Davis DR grading:
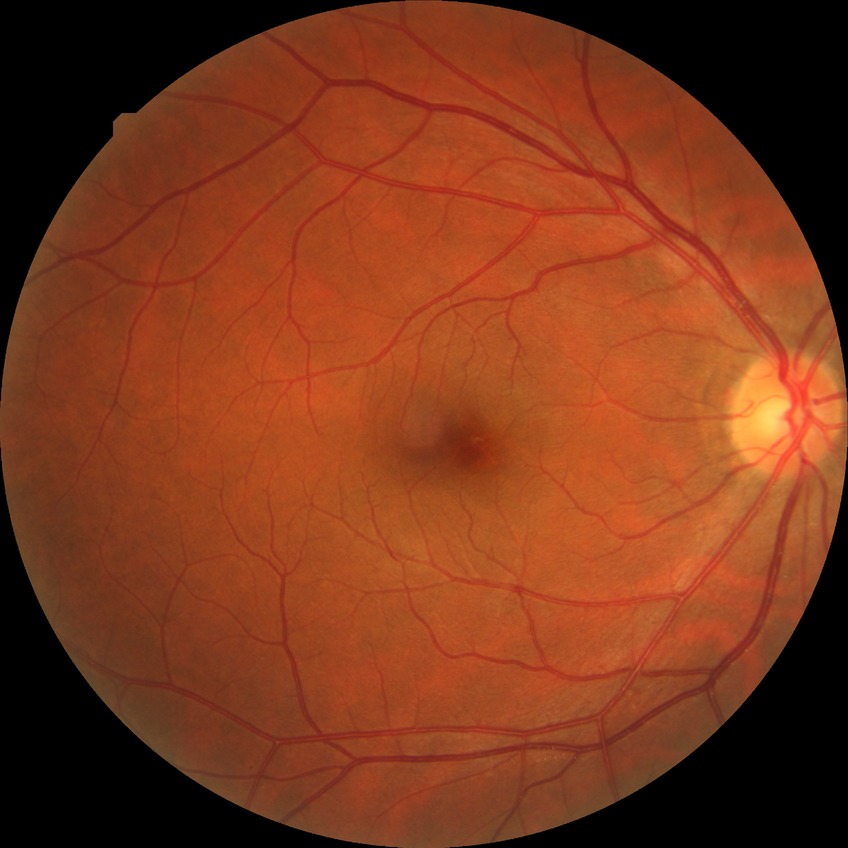   davis_grade: no diabetic retinopathy (NDR)